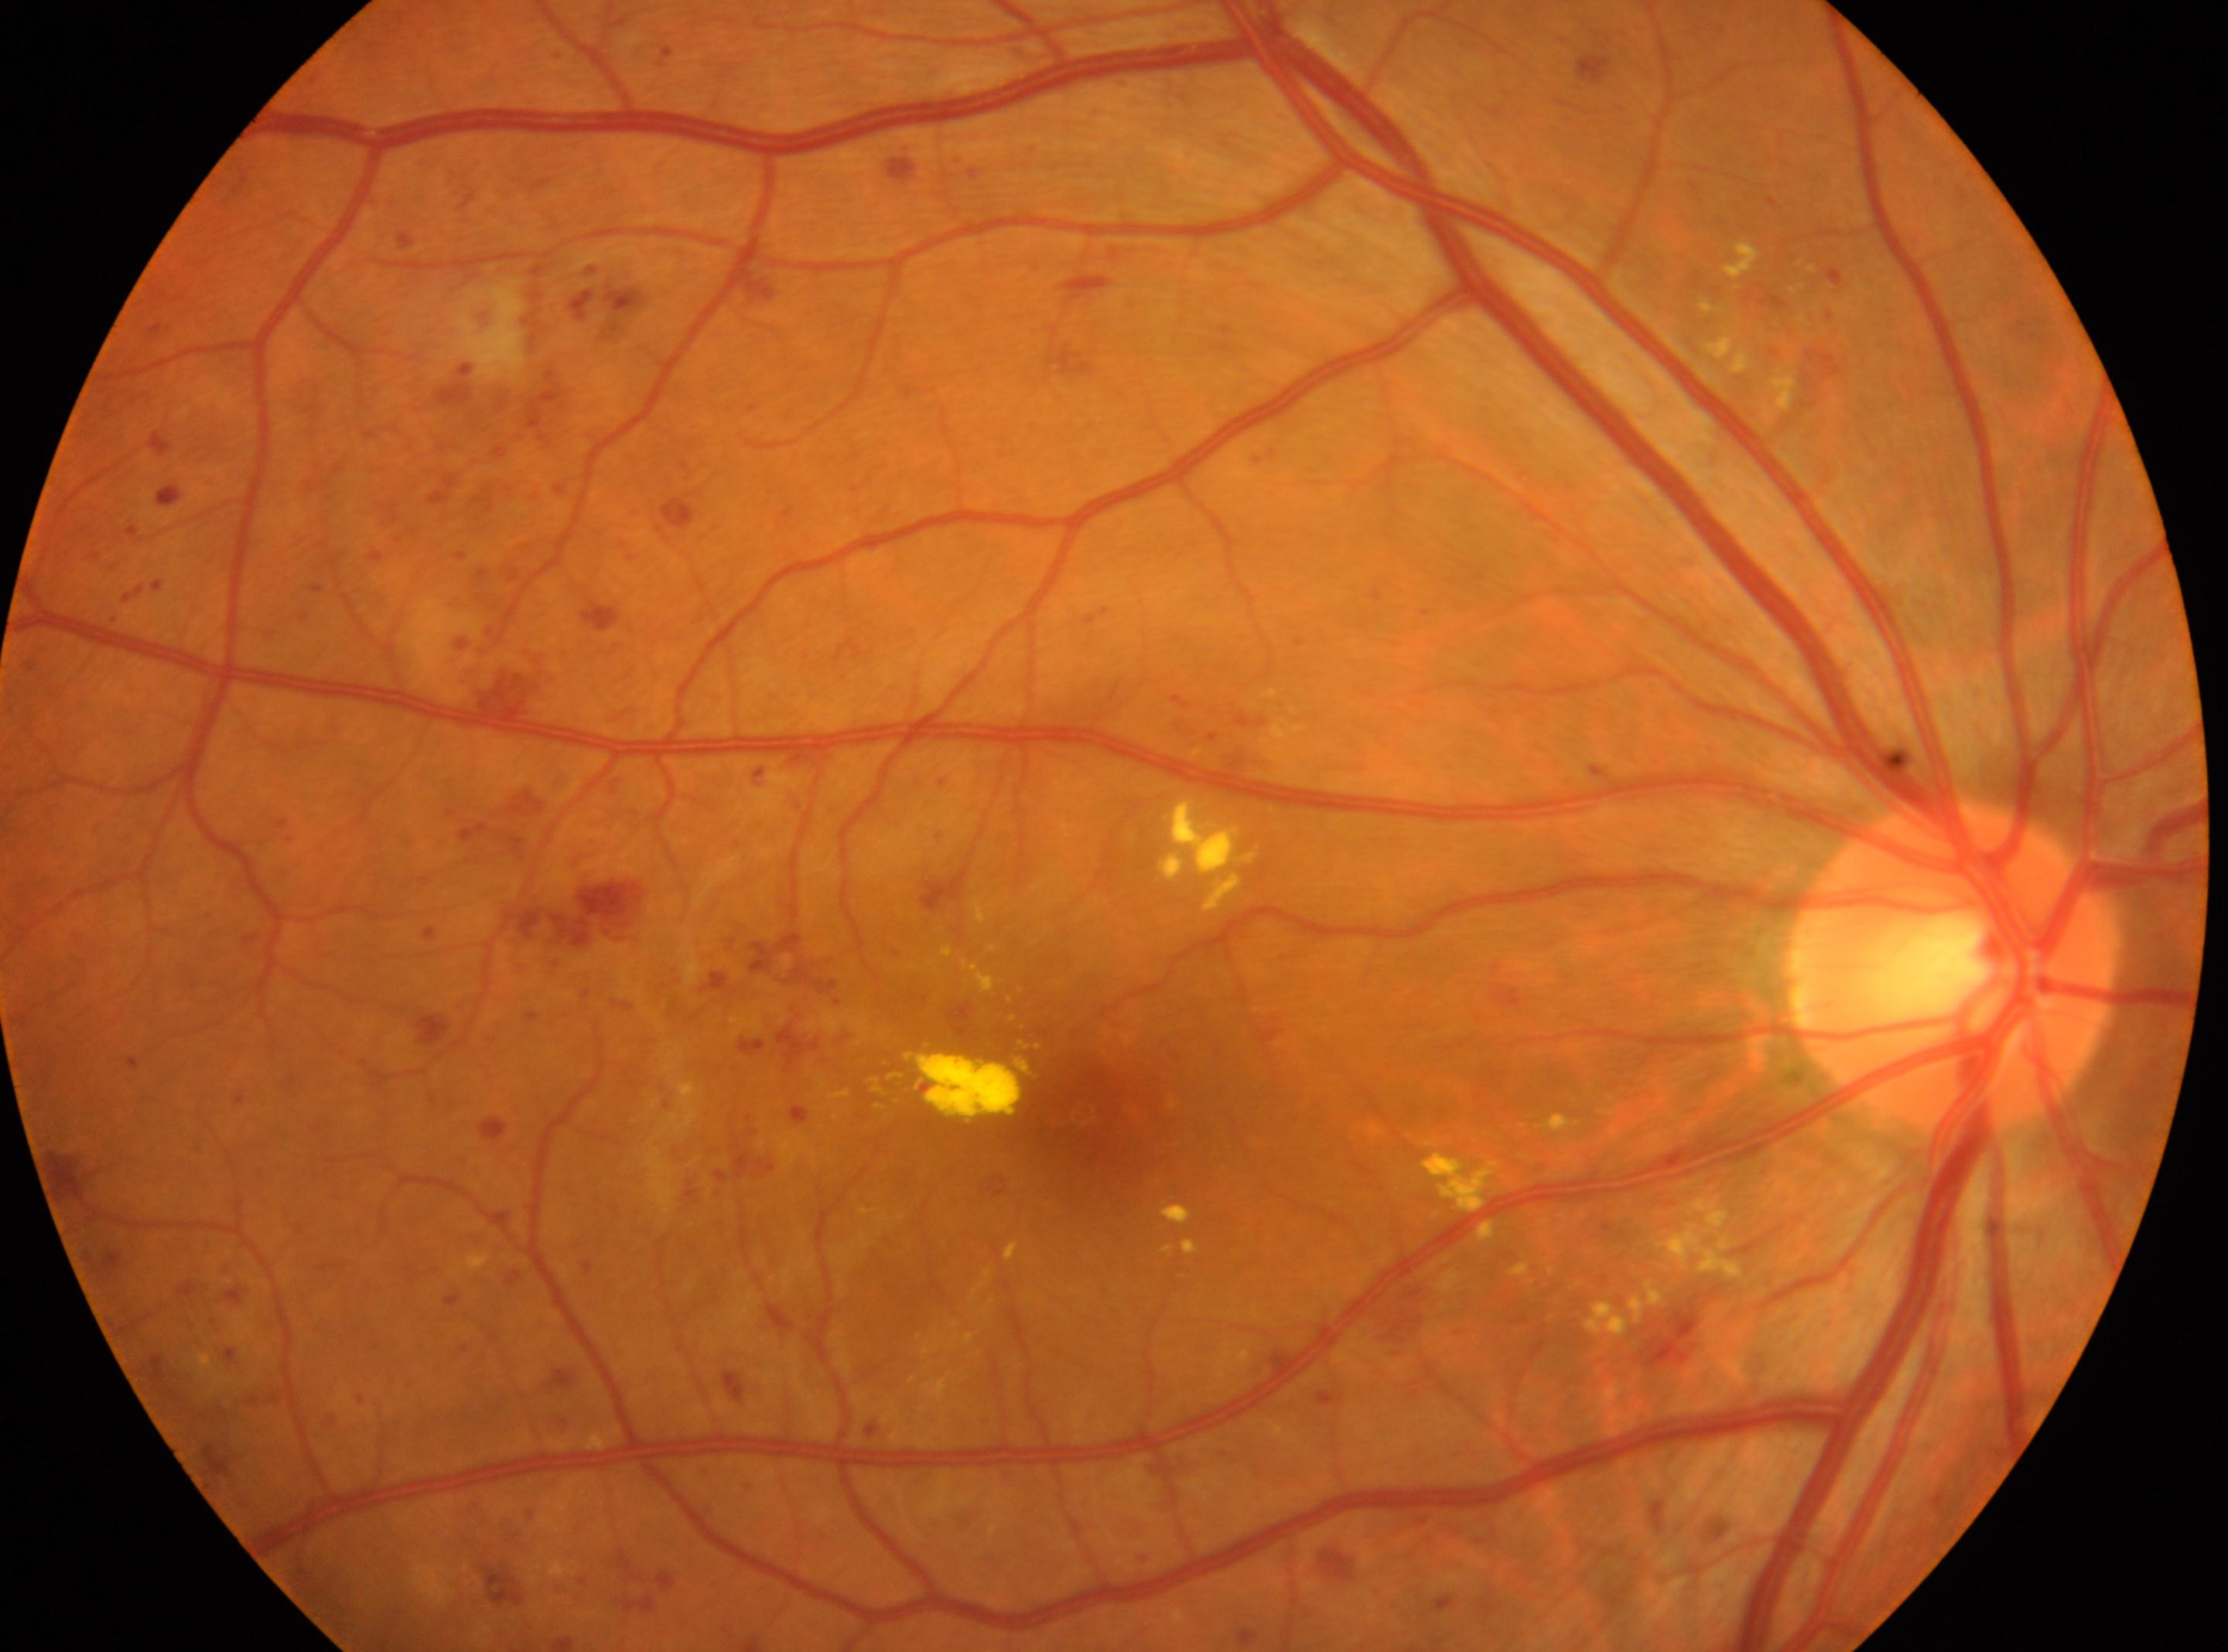
the optic disc = [1952, 964]
DR severity = grade 3 — more than 20 intraretinal hemorrhages in each of 4 quadrants, definite venous beading in 2 or more quadrants, or prominent intraretinal microvascular abnormalities in 1 or more quadrants, with no signs of proliferative retinopathy
foveal center = [1086, 1114]
laterality = the right eye